Pediatric retinal photograph (wide-field): 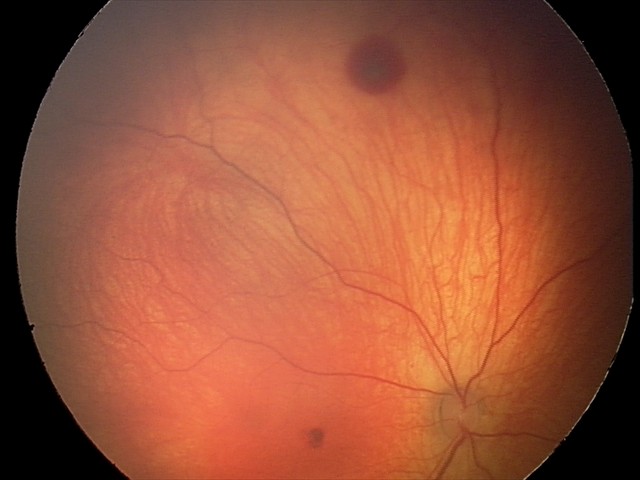 Screening examination consistent with retinal hemorrhages.